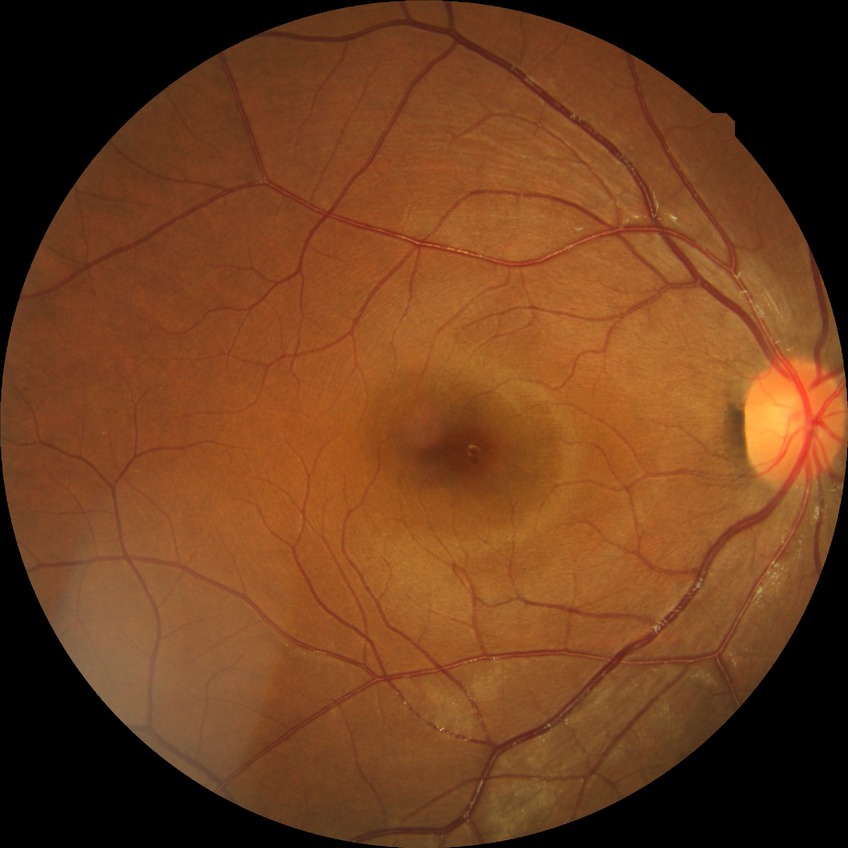 Retinopathy stage is no diabetic retinopathy.